2346x1568. CFP.
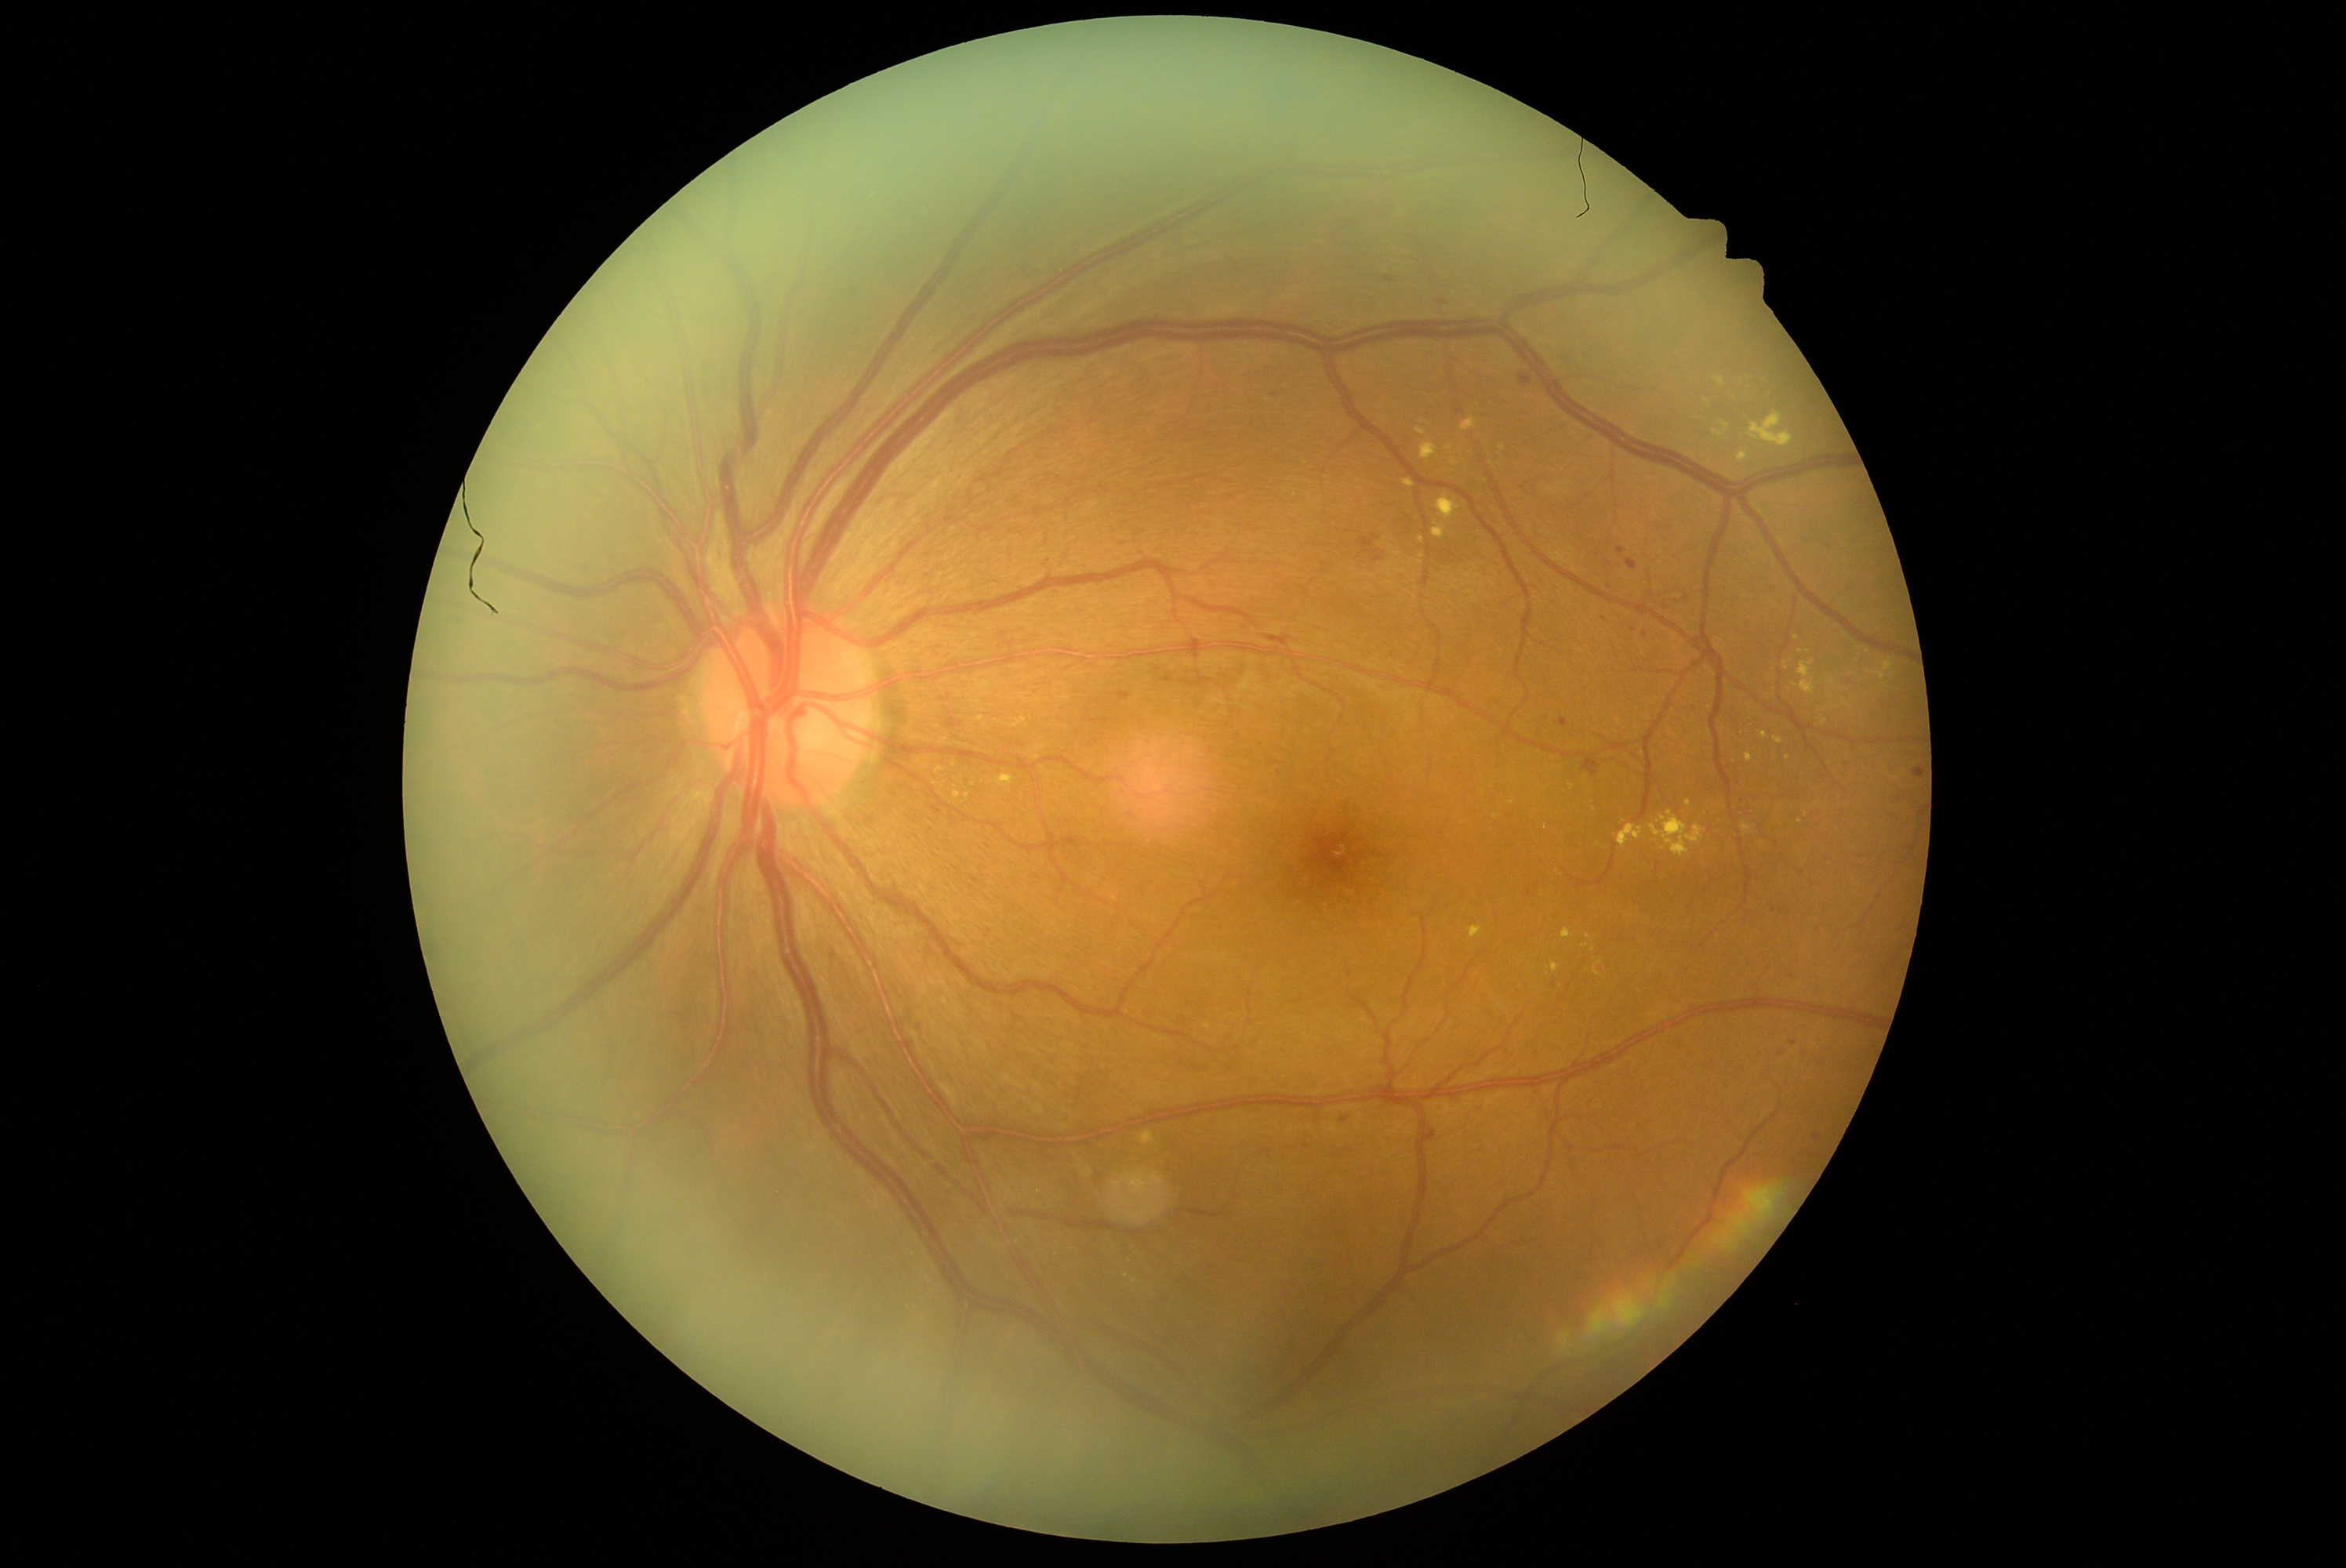 <lesions partial="true">
  <dr_grade>2</dr_grade>
  <ex partial="true">1561 929 1572 940 | 1451 460 1459 466 | 1431 523 1445 540 | 1741 824 1754 837 | 1716 377 1726 388 | 1619 824 1644 849 | 1651 811 1705 857 | 1713 429 1724 437 | 1746 753 1754 763</ex>
  <ex_small>1853/675 | 1495/817 | 1807/814 | 1825/722 | 1134/1281 | 1207/1027 | 1587/945</ex_small>
  <he partial="true">1340 1116 1351 1123 | 1625 559 1638 572 | 1583 758 1600 777 | 1384 277 1396 285 | 1560 717 1567 727 | 1434 292 1462 307 | 1373 556 1382 562 | 1842 677 1853 688</he>
  <he_small>1788/912 | 1279/773 | 1805/1055 | 1601/967 | 1793/1043 | 1360/557 | 1751/722 | 1621/876 | 1554/986</he_small>
</lesions>